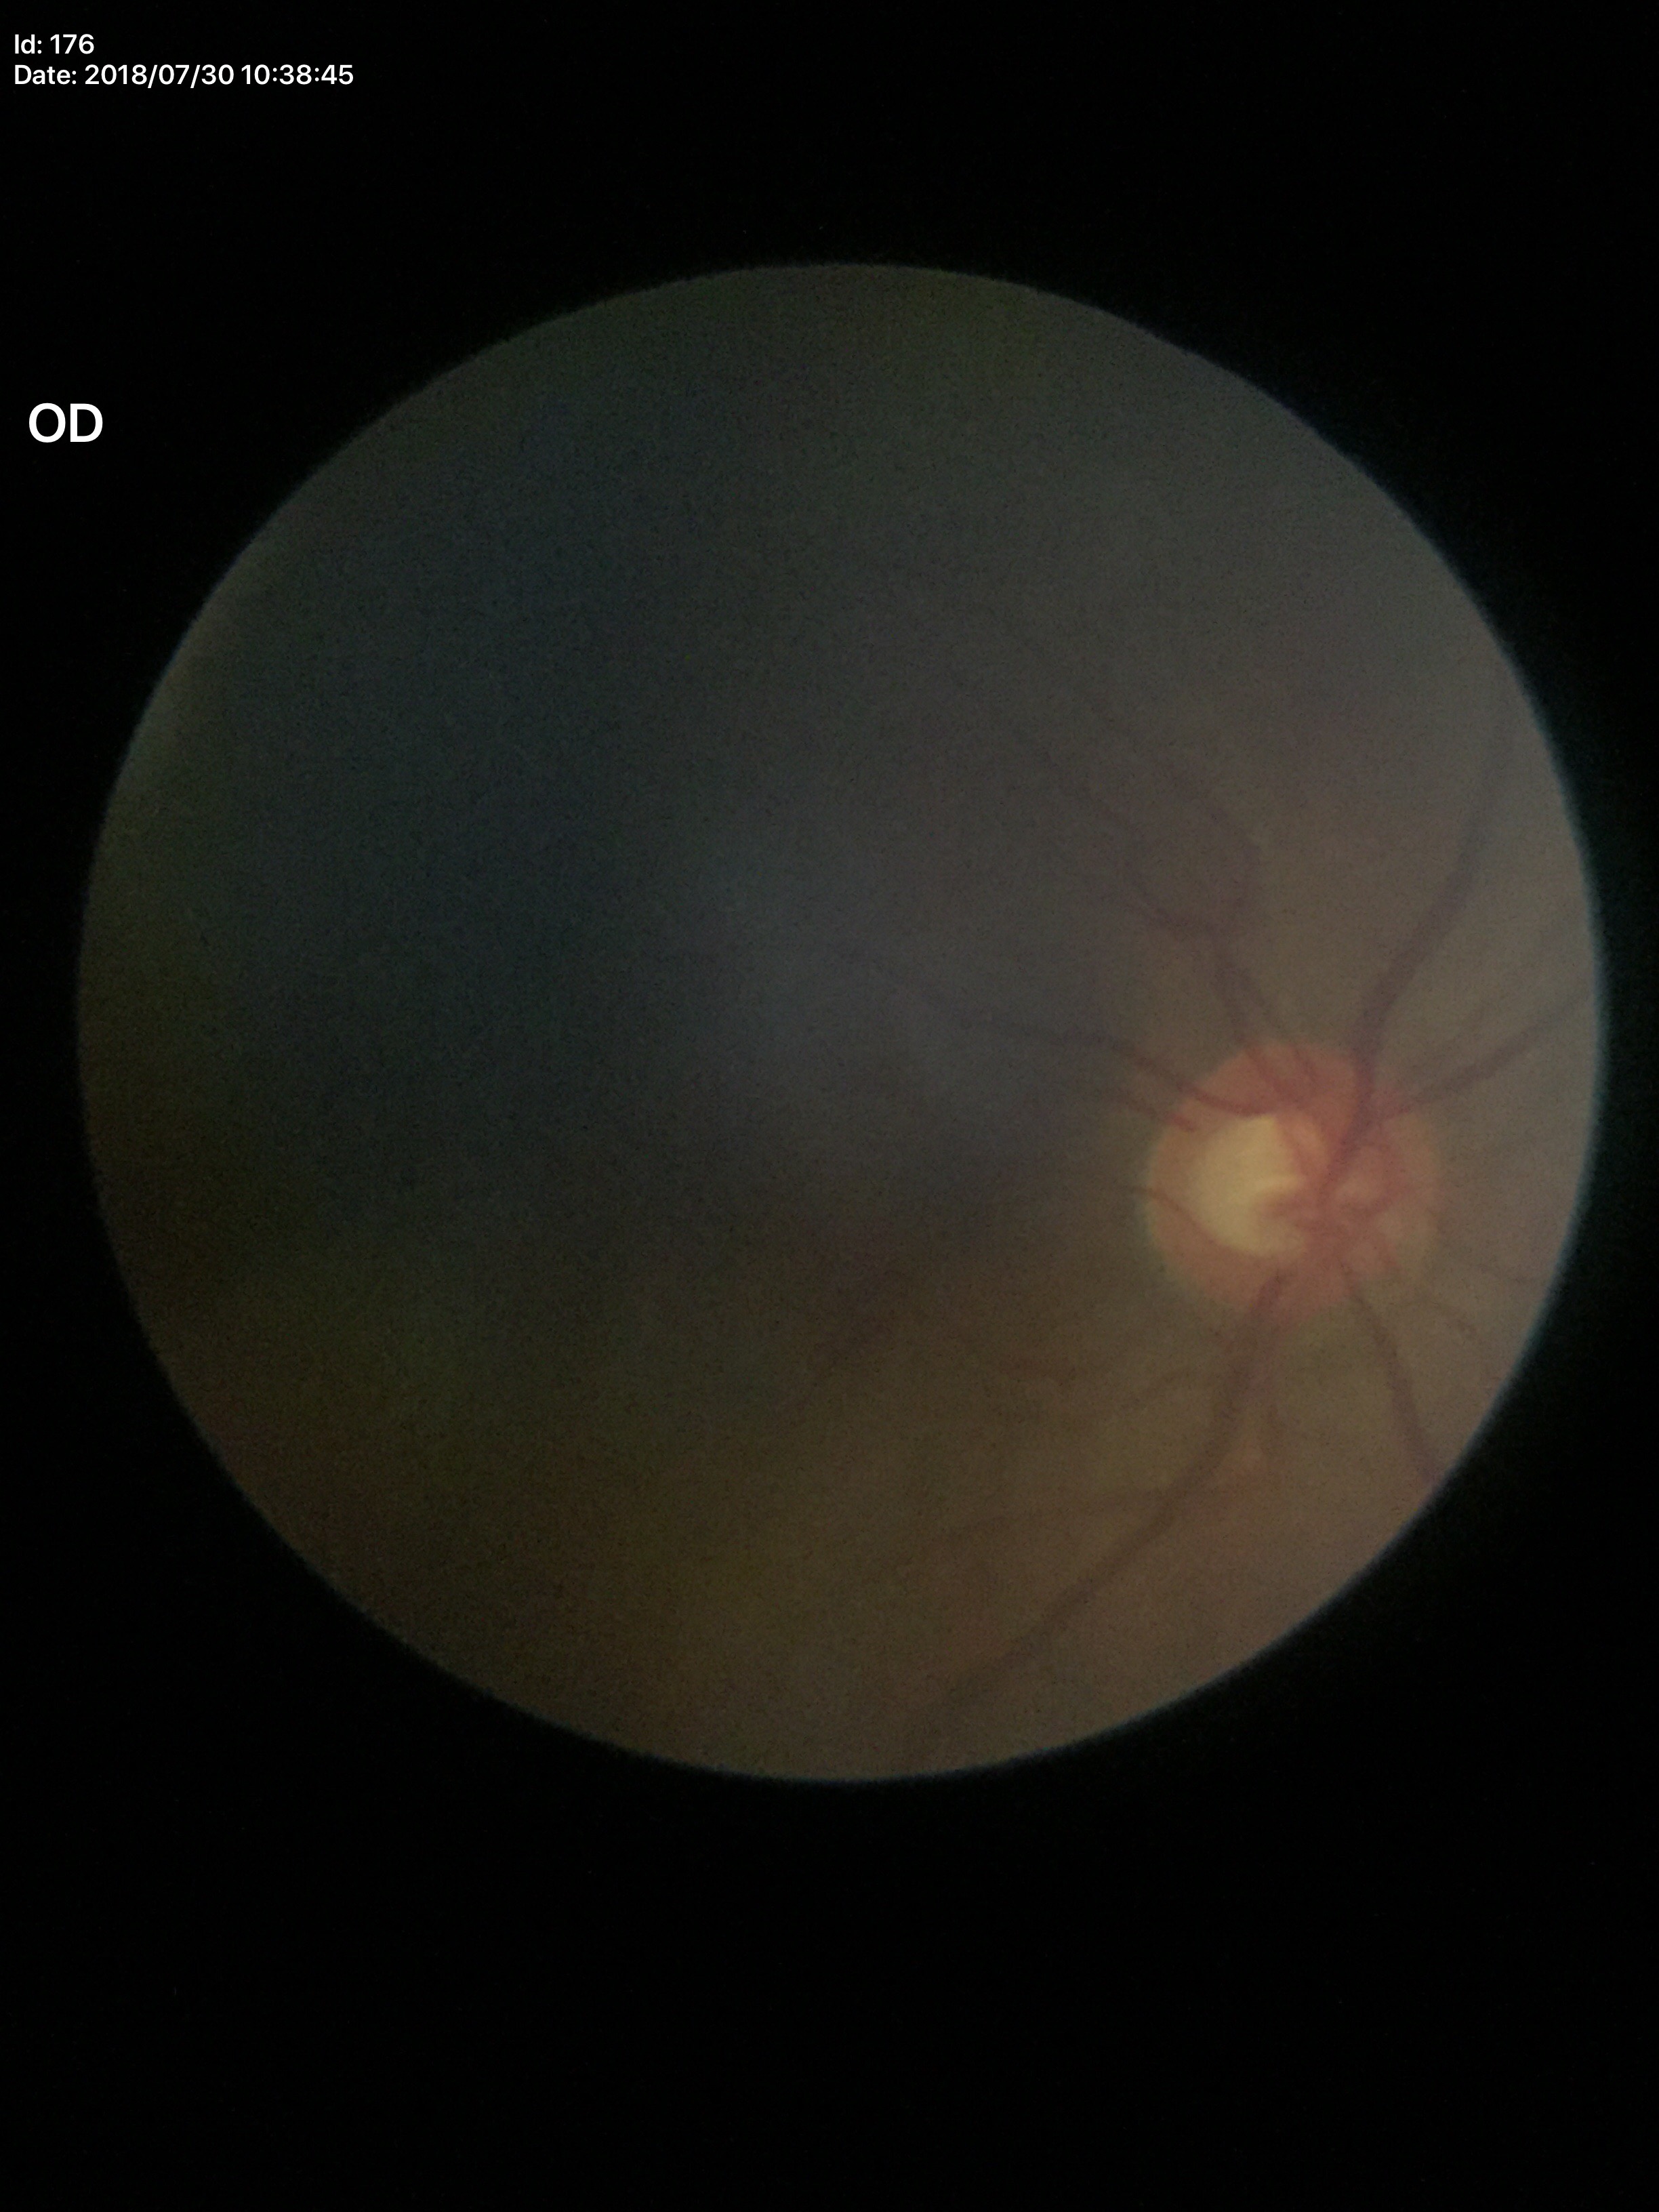

Q: What is the glaucoma assessment?
A: not suspect (all 5 graders called normal)
Q: What is the vertical cup-to-disc ratio?
A: 0.54